Visual field mean deviation: -13.66 dB · color fundus image · undilated pupil:
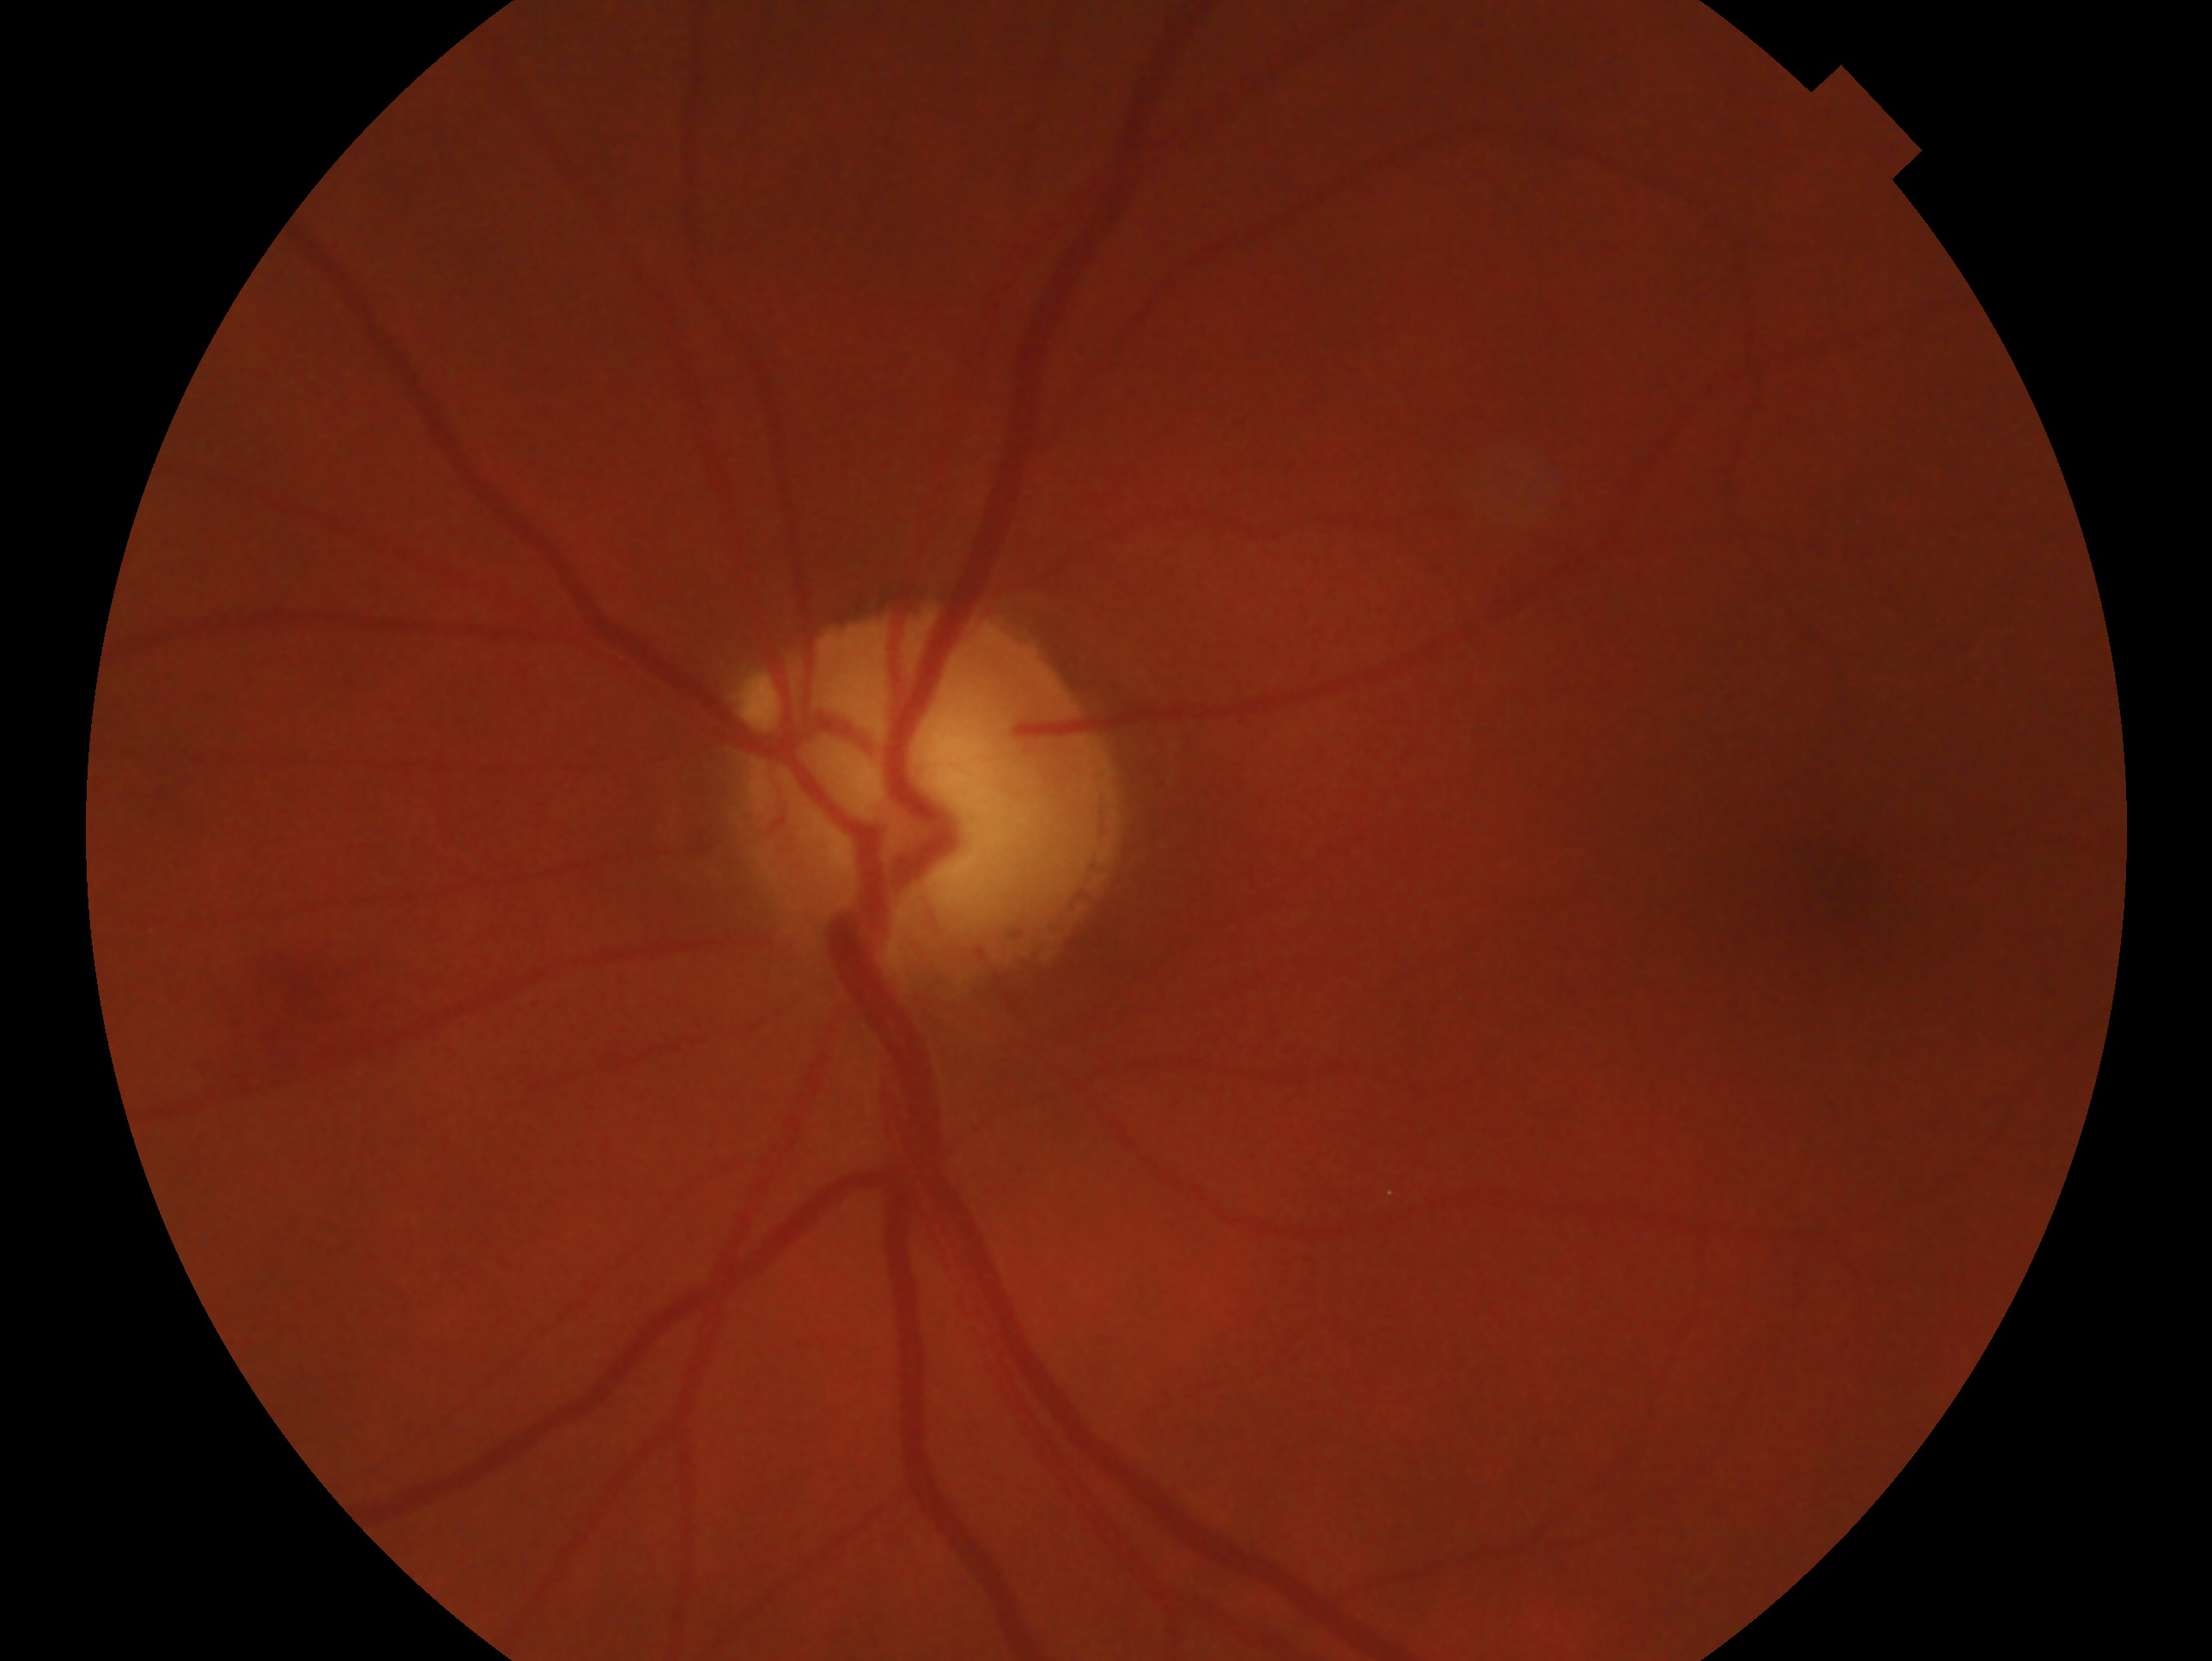
Eye: left. Glaucoma diagnosis: consistent with glaucoma — clinically confirmed glaucoma with characteristic optic nerve damage.